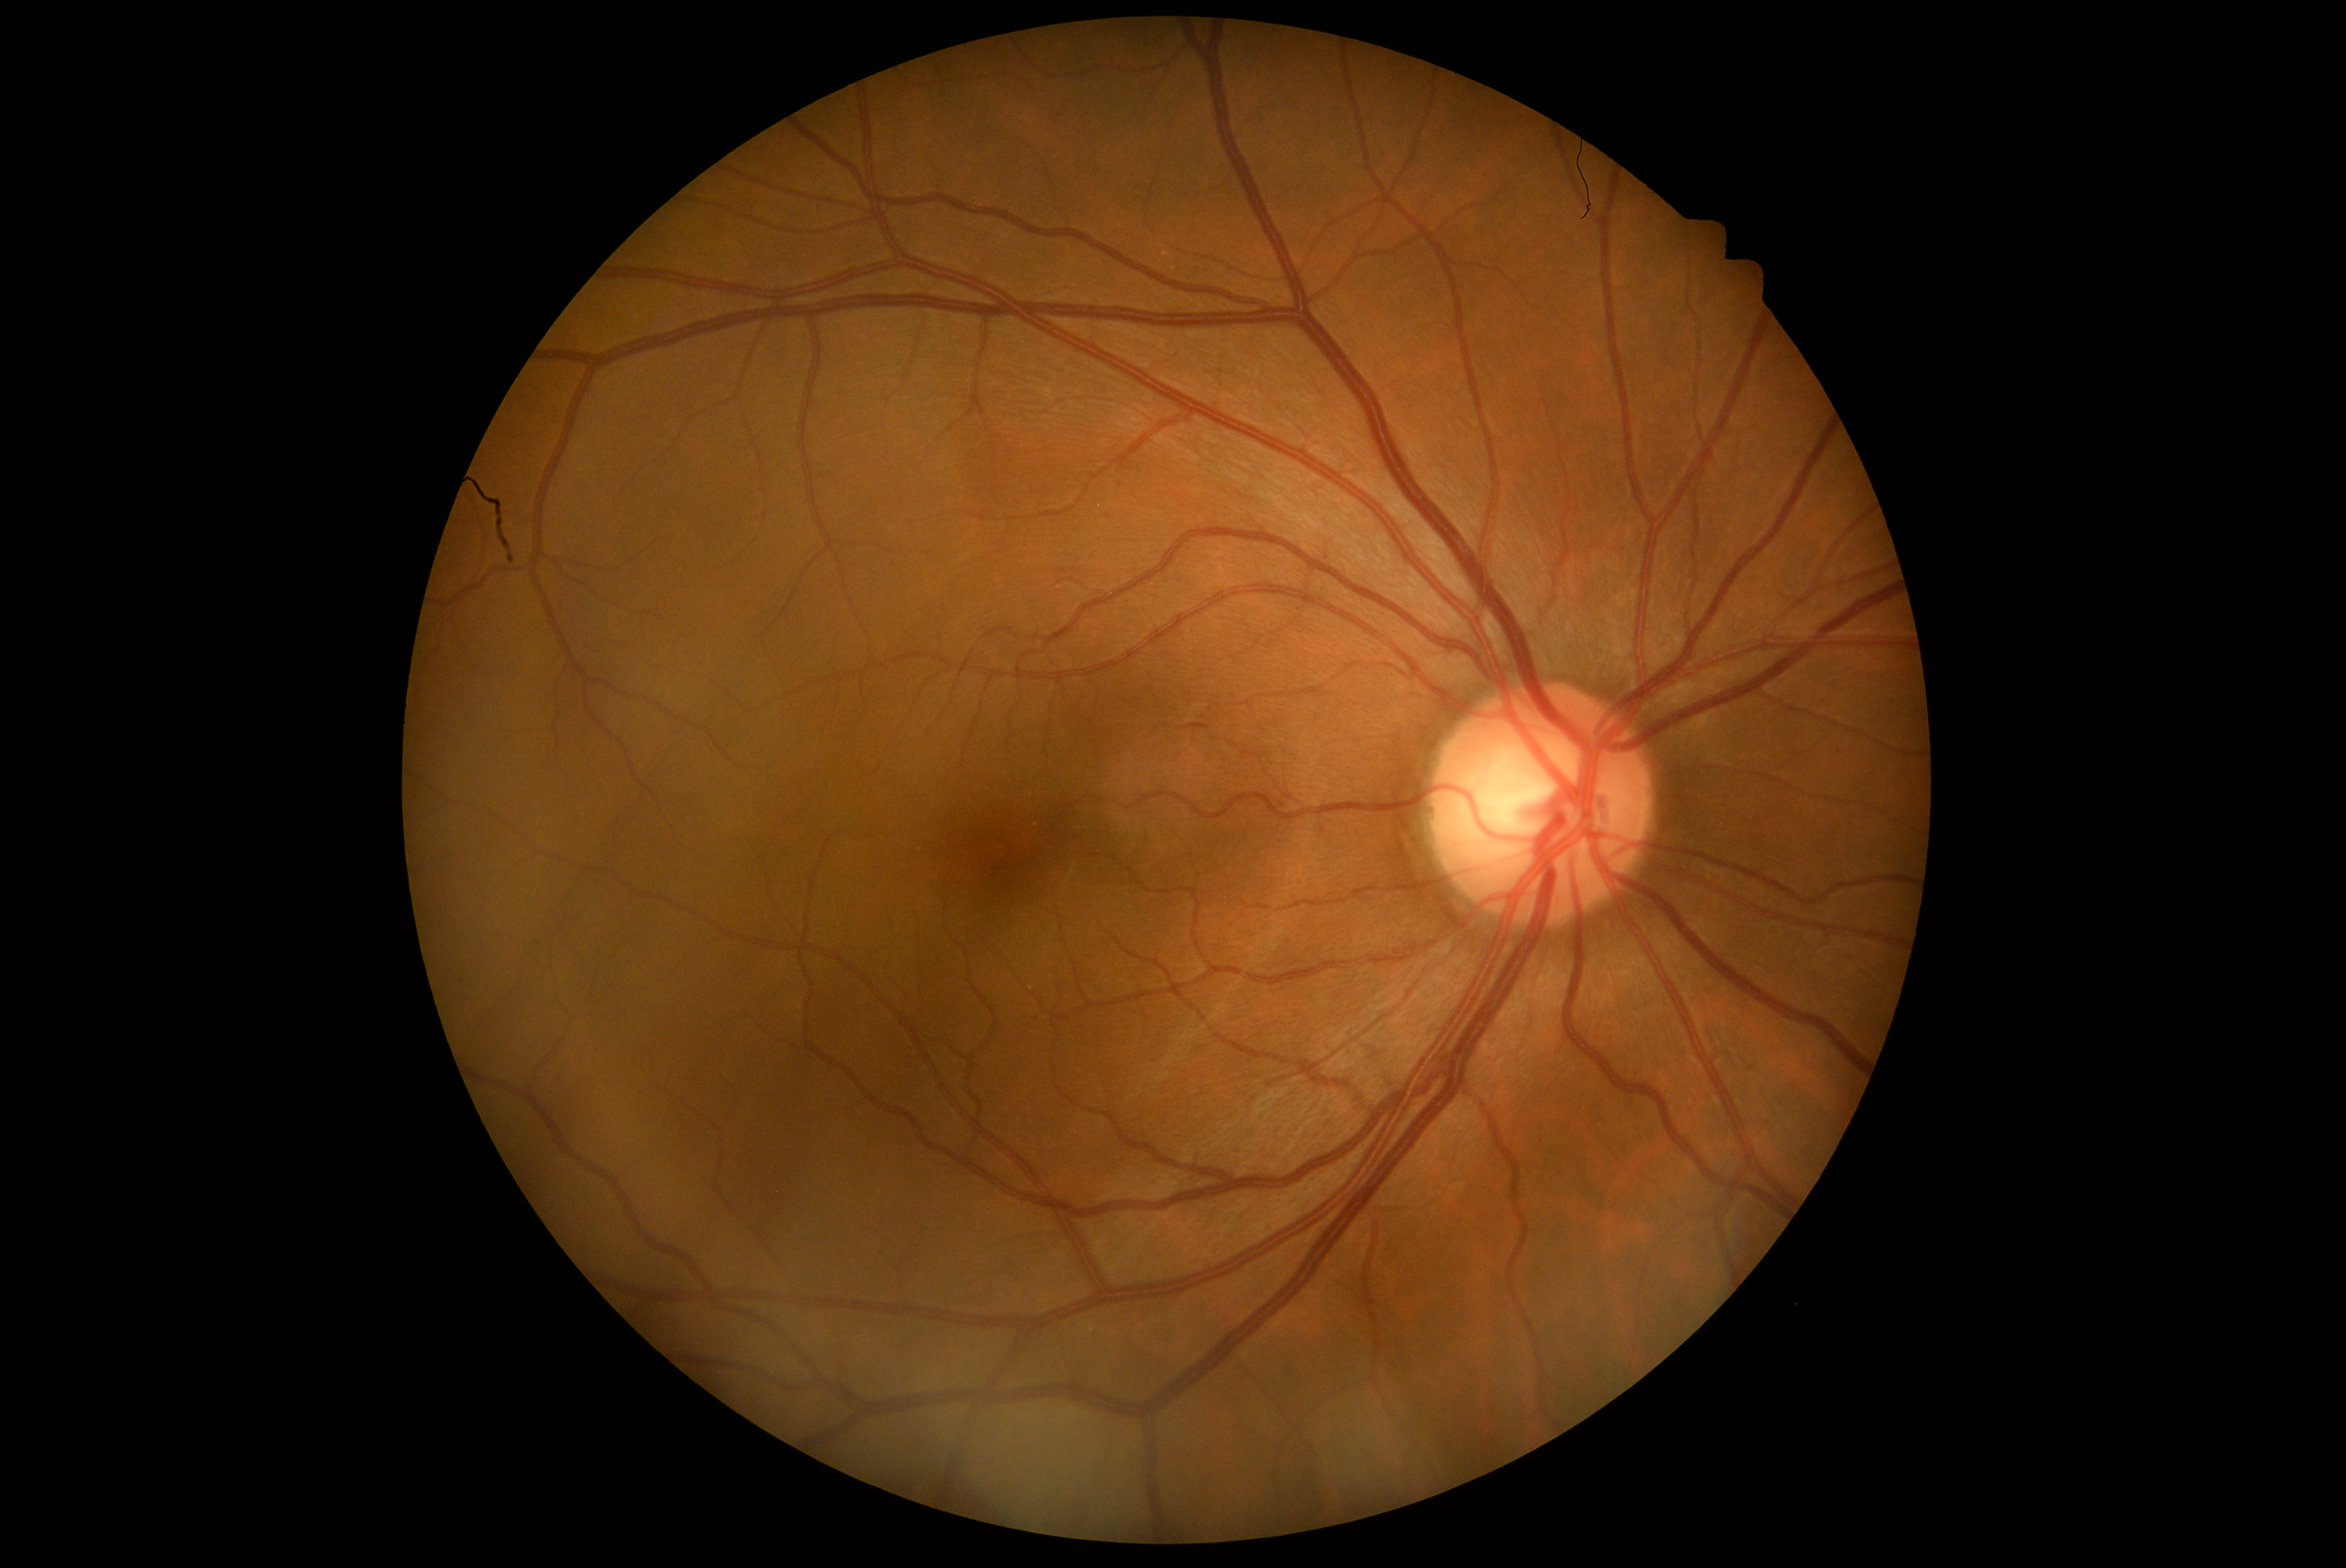

Retinopathy grade: 0. No signs of diabetic retinopathy.